Posterior pole color fundus photograph. 45 degree fundus photograph. Image size 848x848. Nonmydriatic. Acquired with a NIDEK AFC-230.
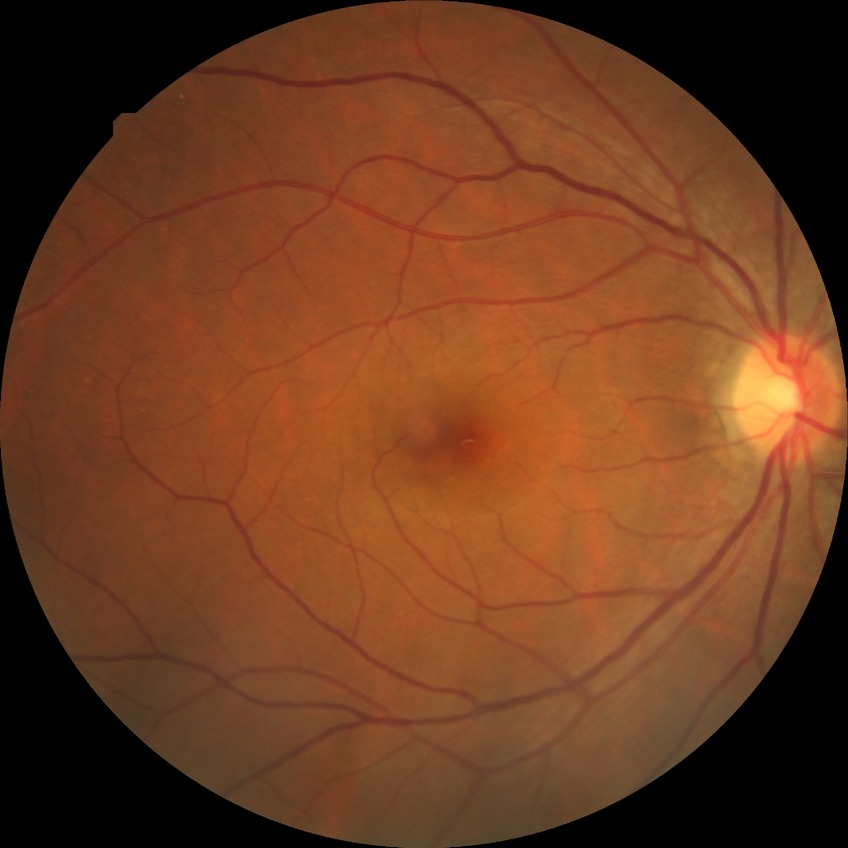
Diabetic retinopathy (DR): no diabetic retinopathy (NDR).